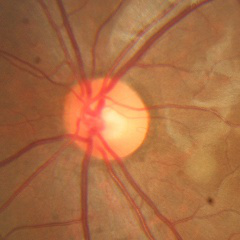
No glaucomatous optic neuropathy.